Wide-field fundus photograph from neonatal ROP screening · 1240 by 1240 pixels:
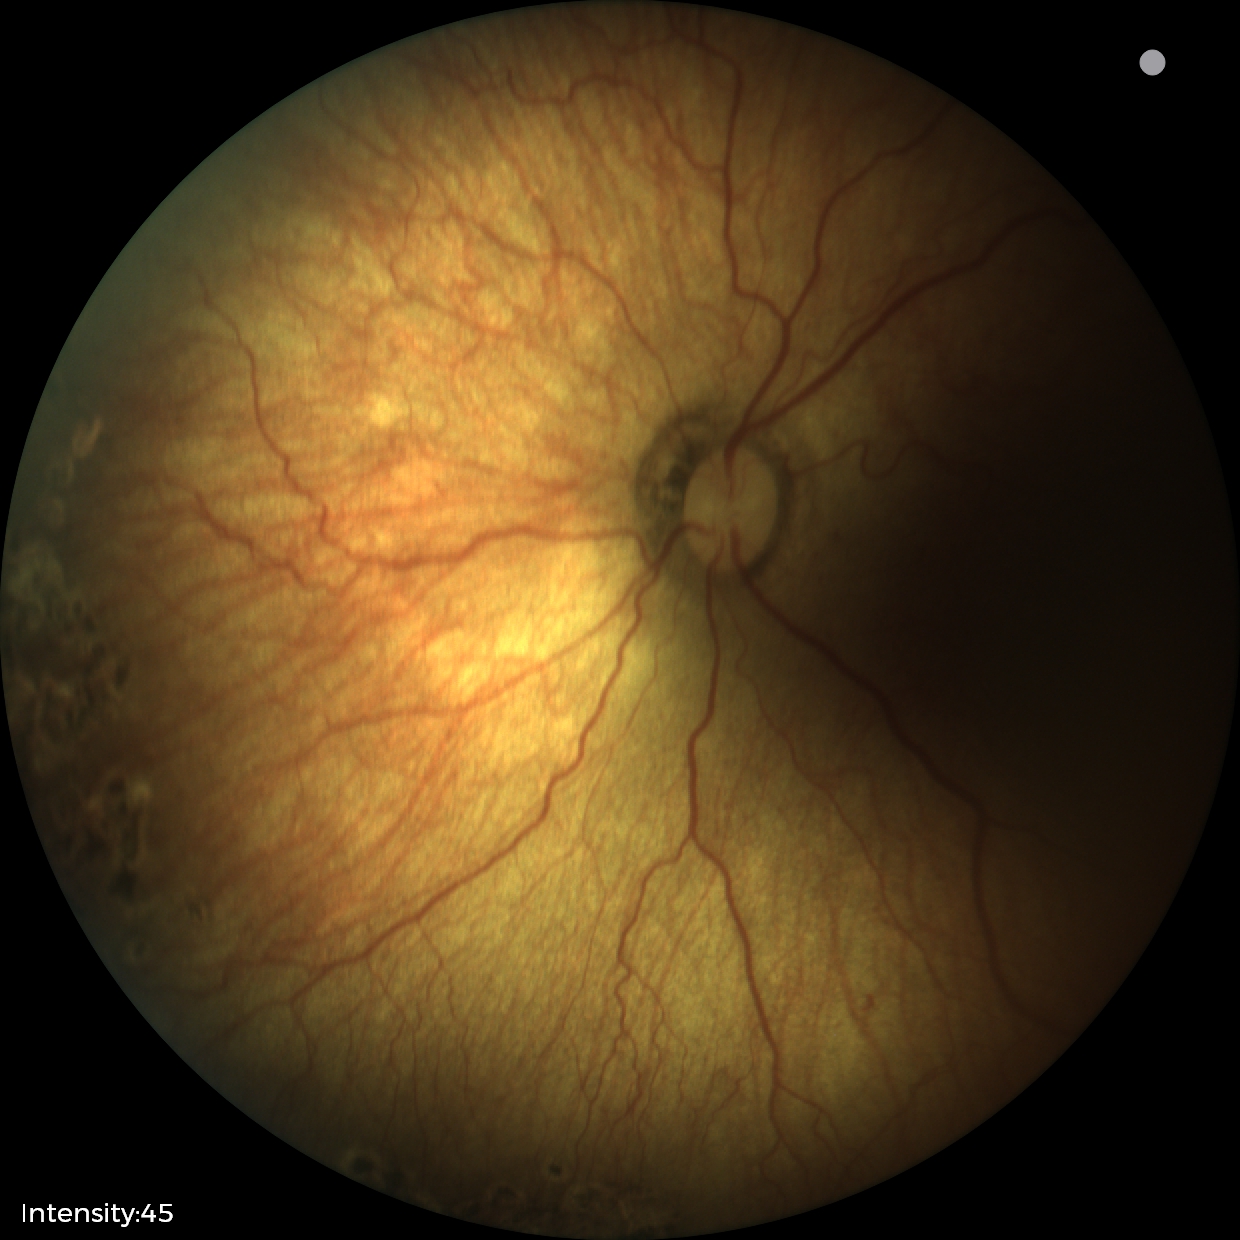 Impression: no plus disease; status post ROP — retinal appearance after treated retinopathy of prematurity.